848x848 — 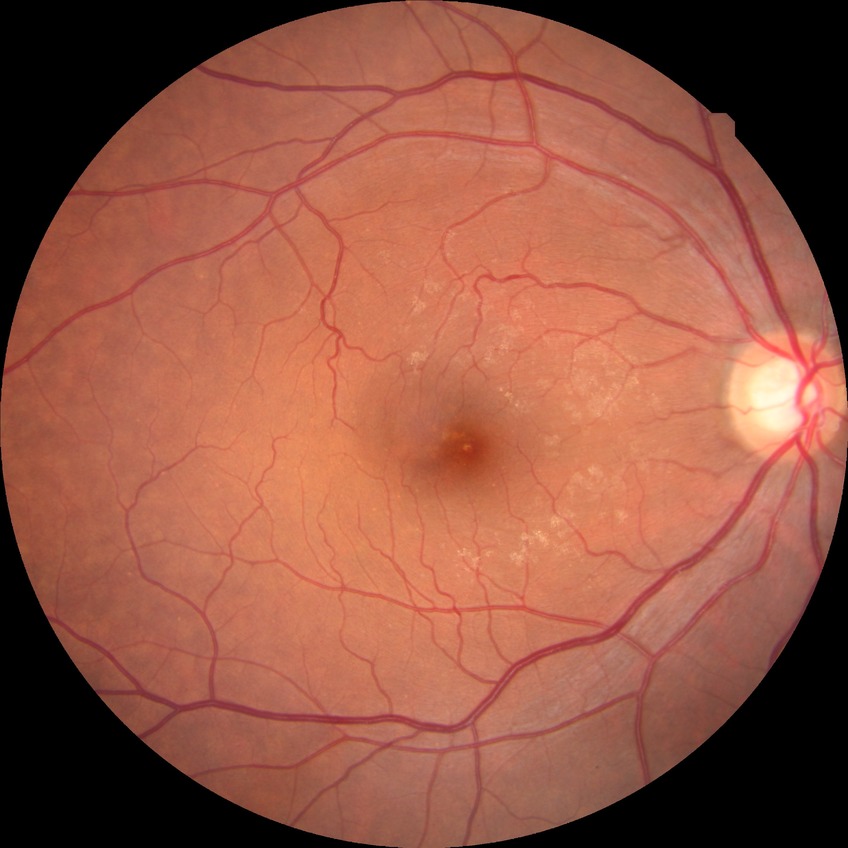 Davis DR grade = NDR.